Infant wide-field retinal image; acquired on the Clarity RetCam 3.
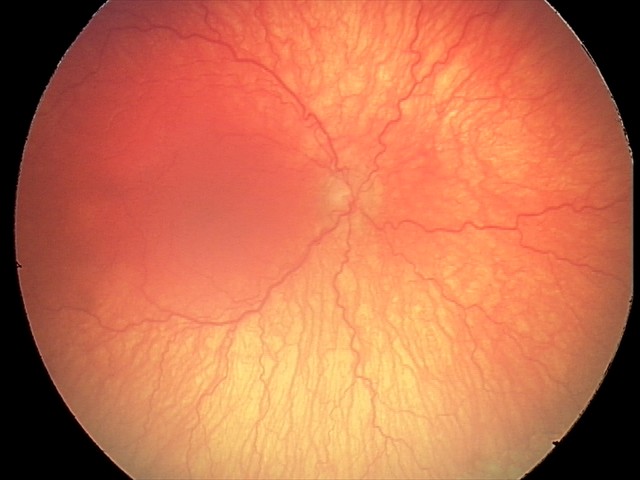

With plus disease. Diagnosis from this screening exam: aggressive retinopathy of prematurity.